Clarity RetCam 3, 130° FOV. 640 x 480 pixels. RetCam wide-field infant fundus image — 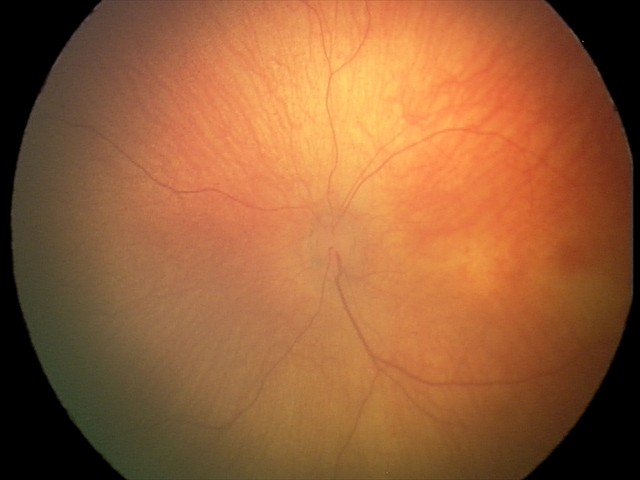

Assessment: physiological finding.